Captured on a Remidio FOP fundus camera, 1659x2212px
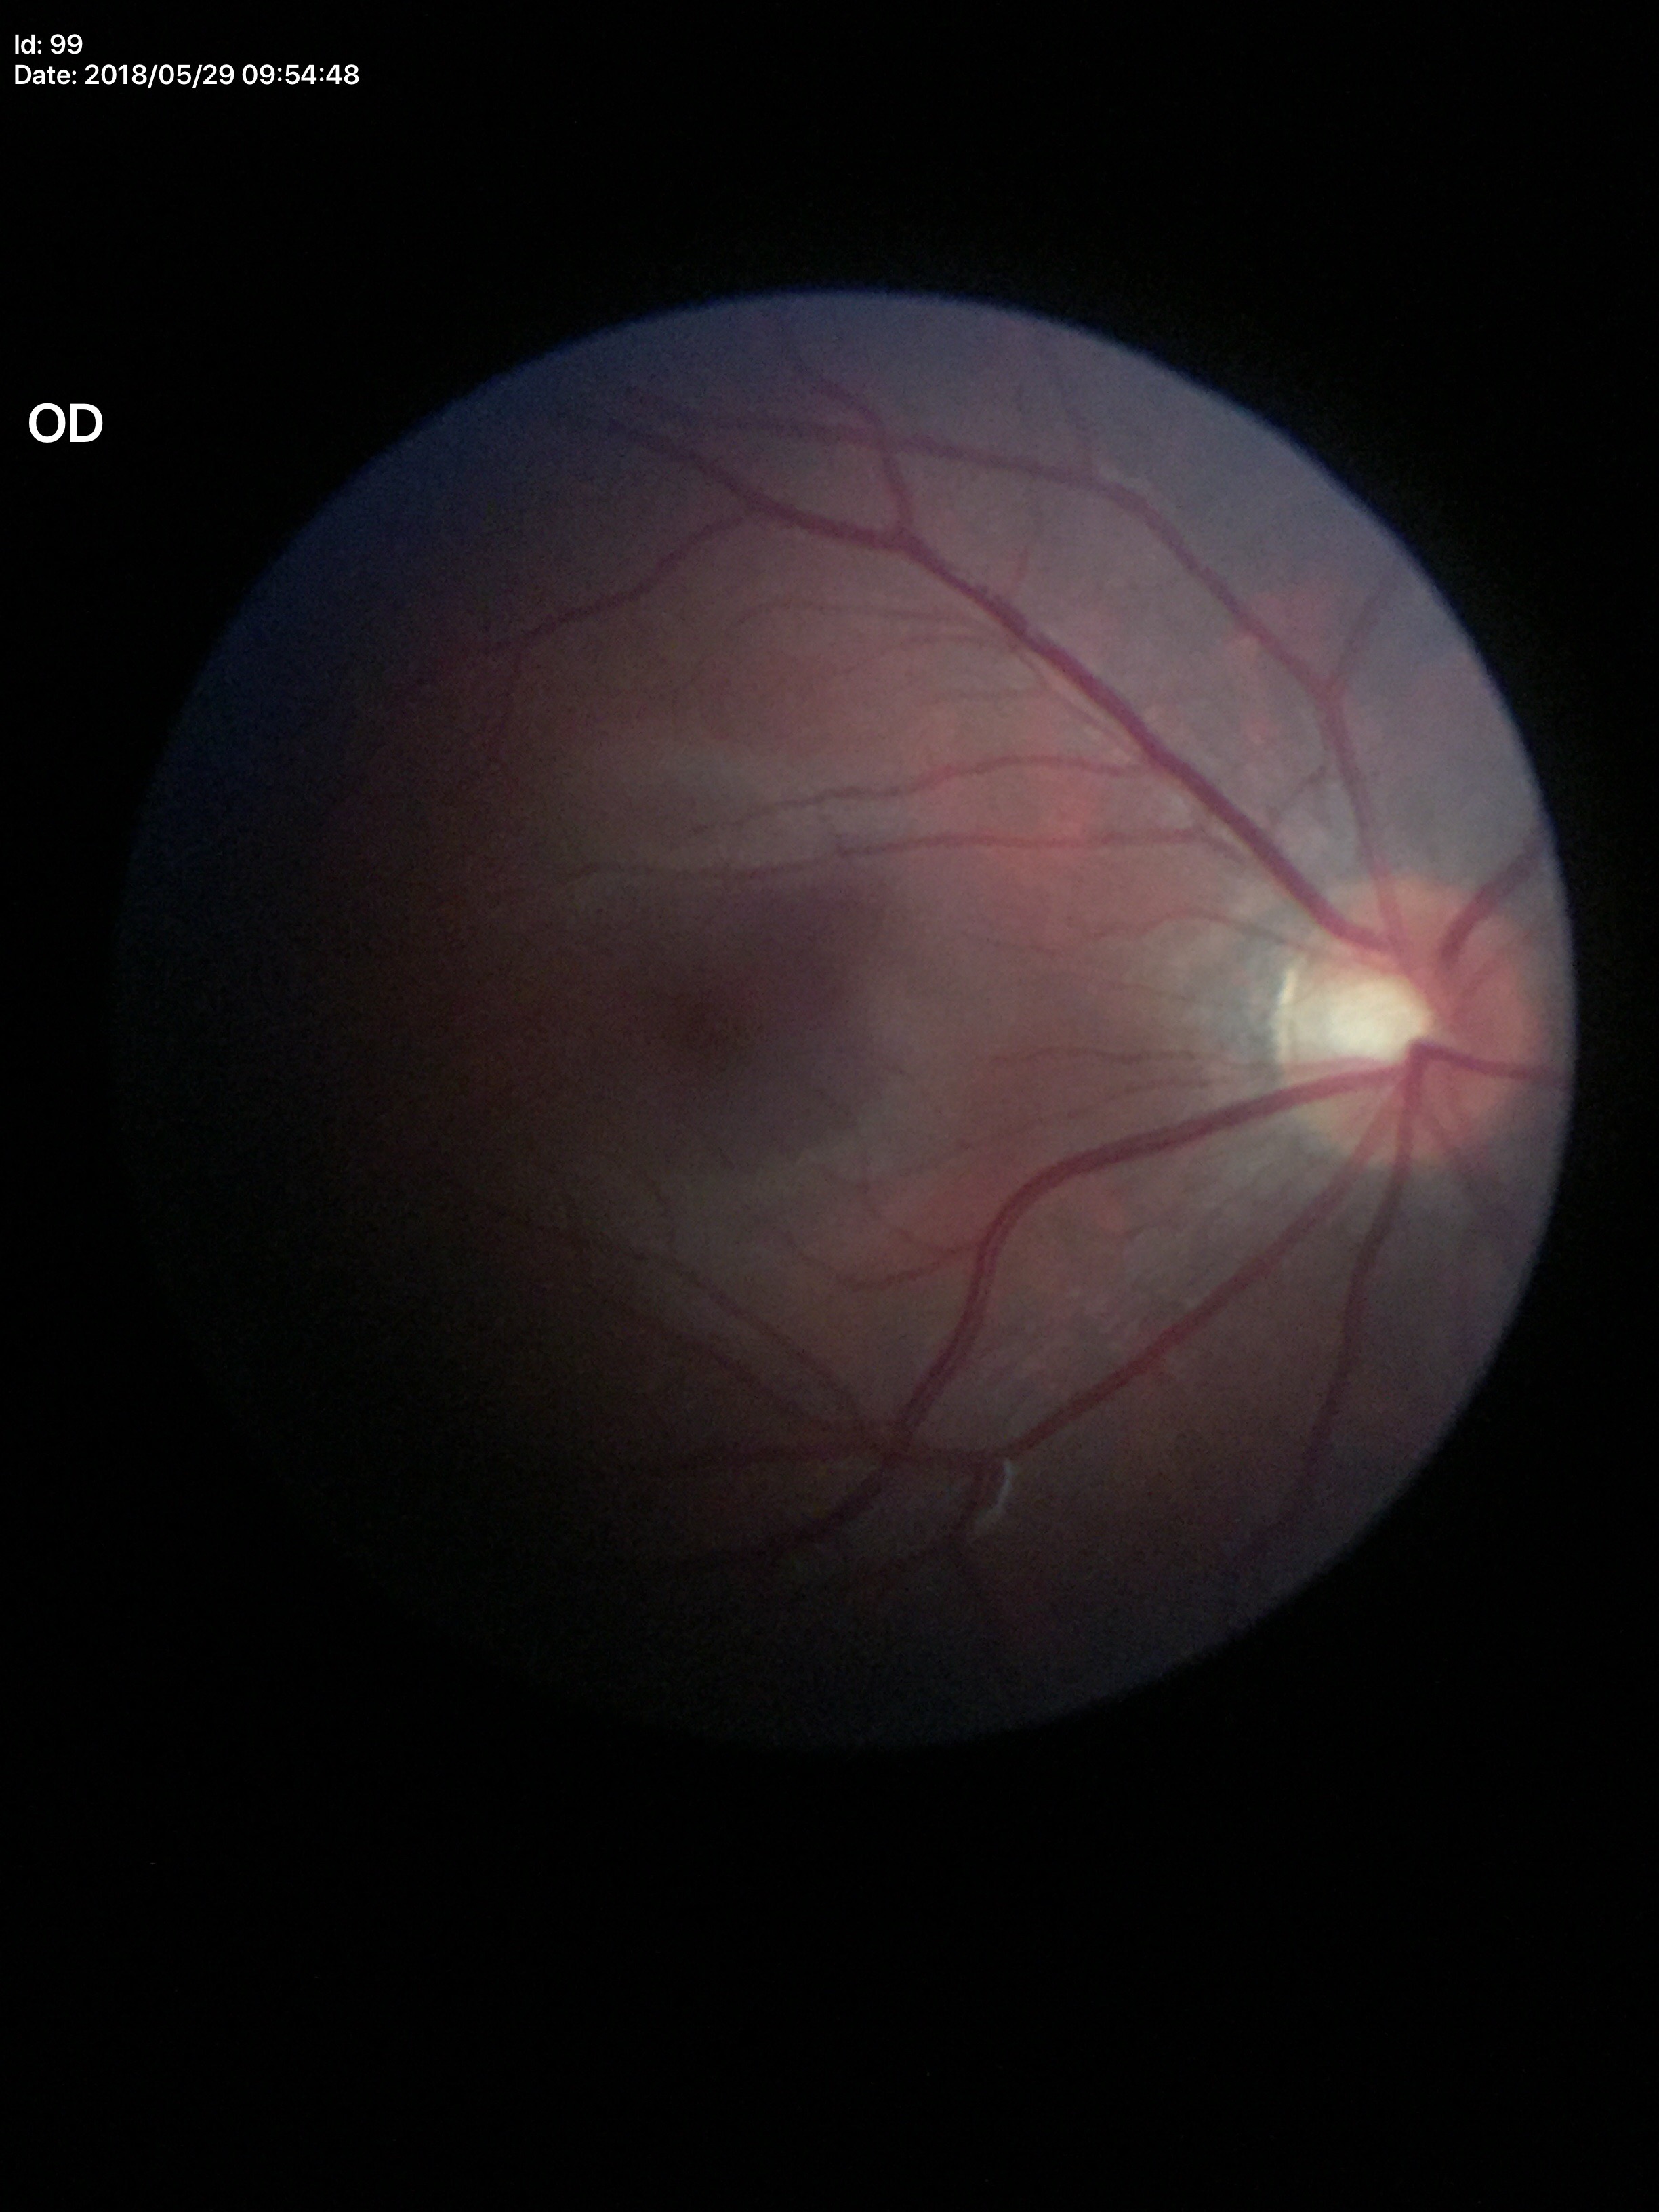
{
  "vcdr": "0.47",
  "glaucoma_decision": "no suspicious findings"
}